Color fundus image; 1932x1932px:
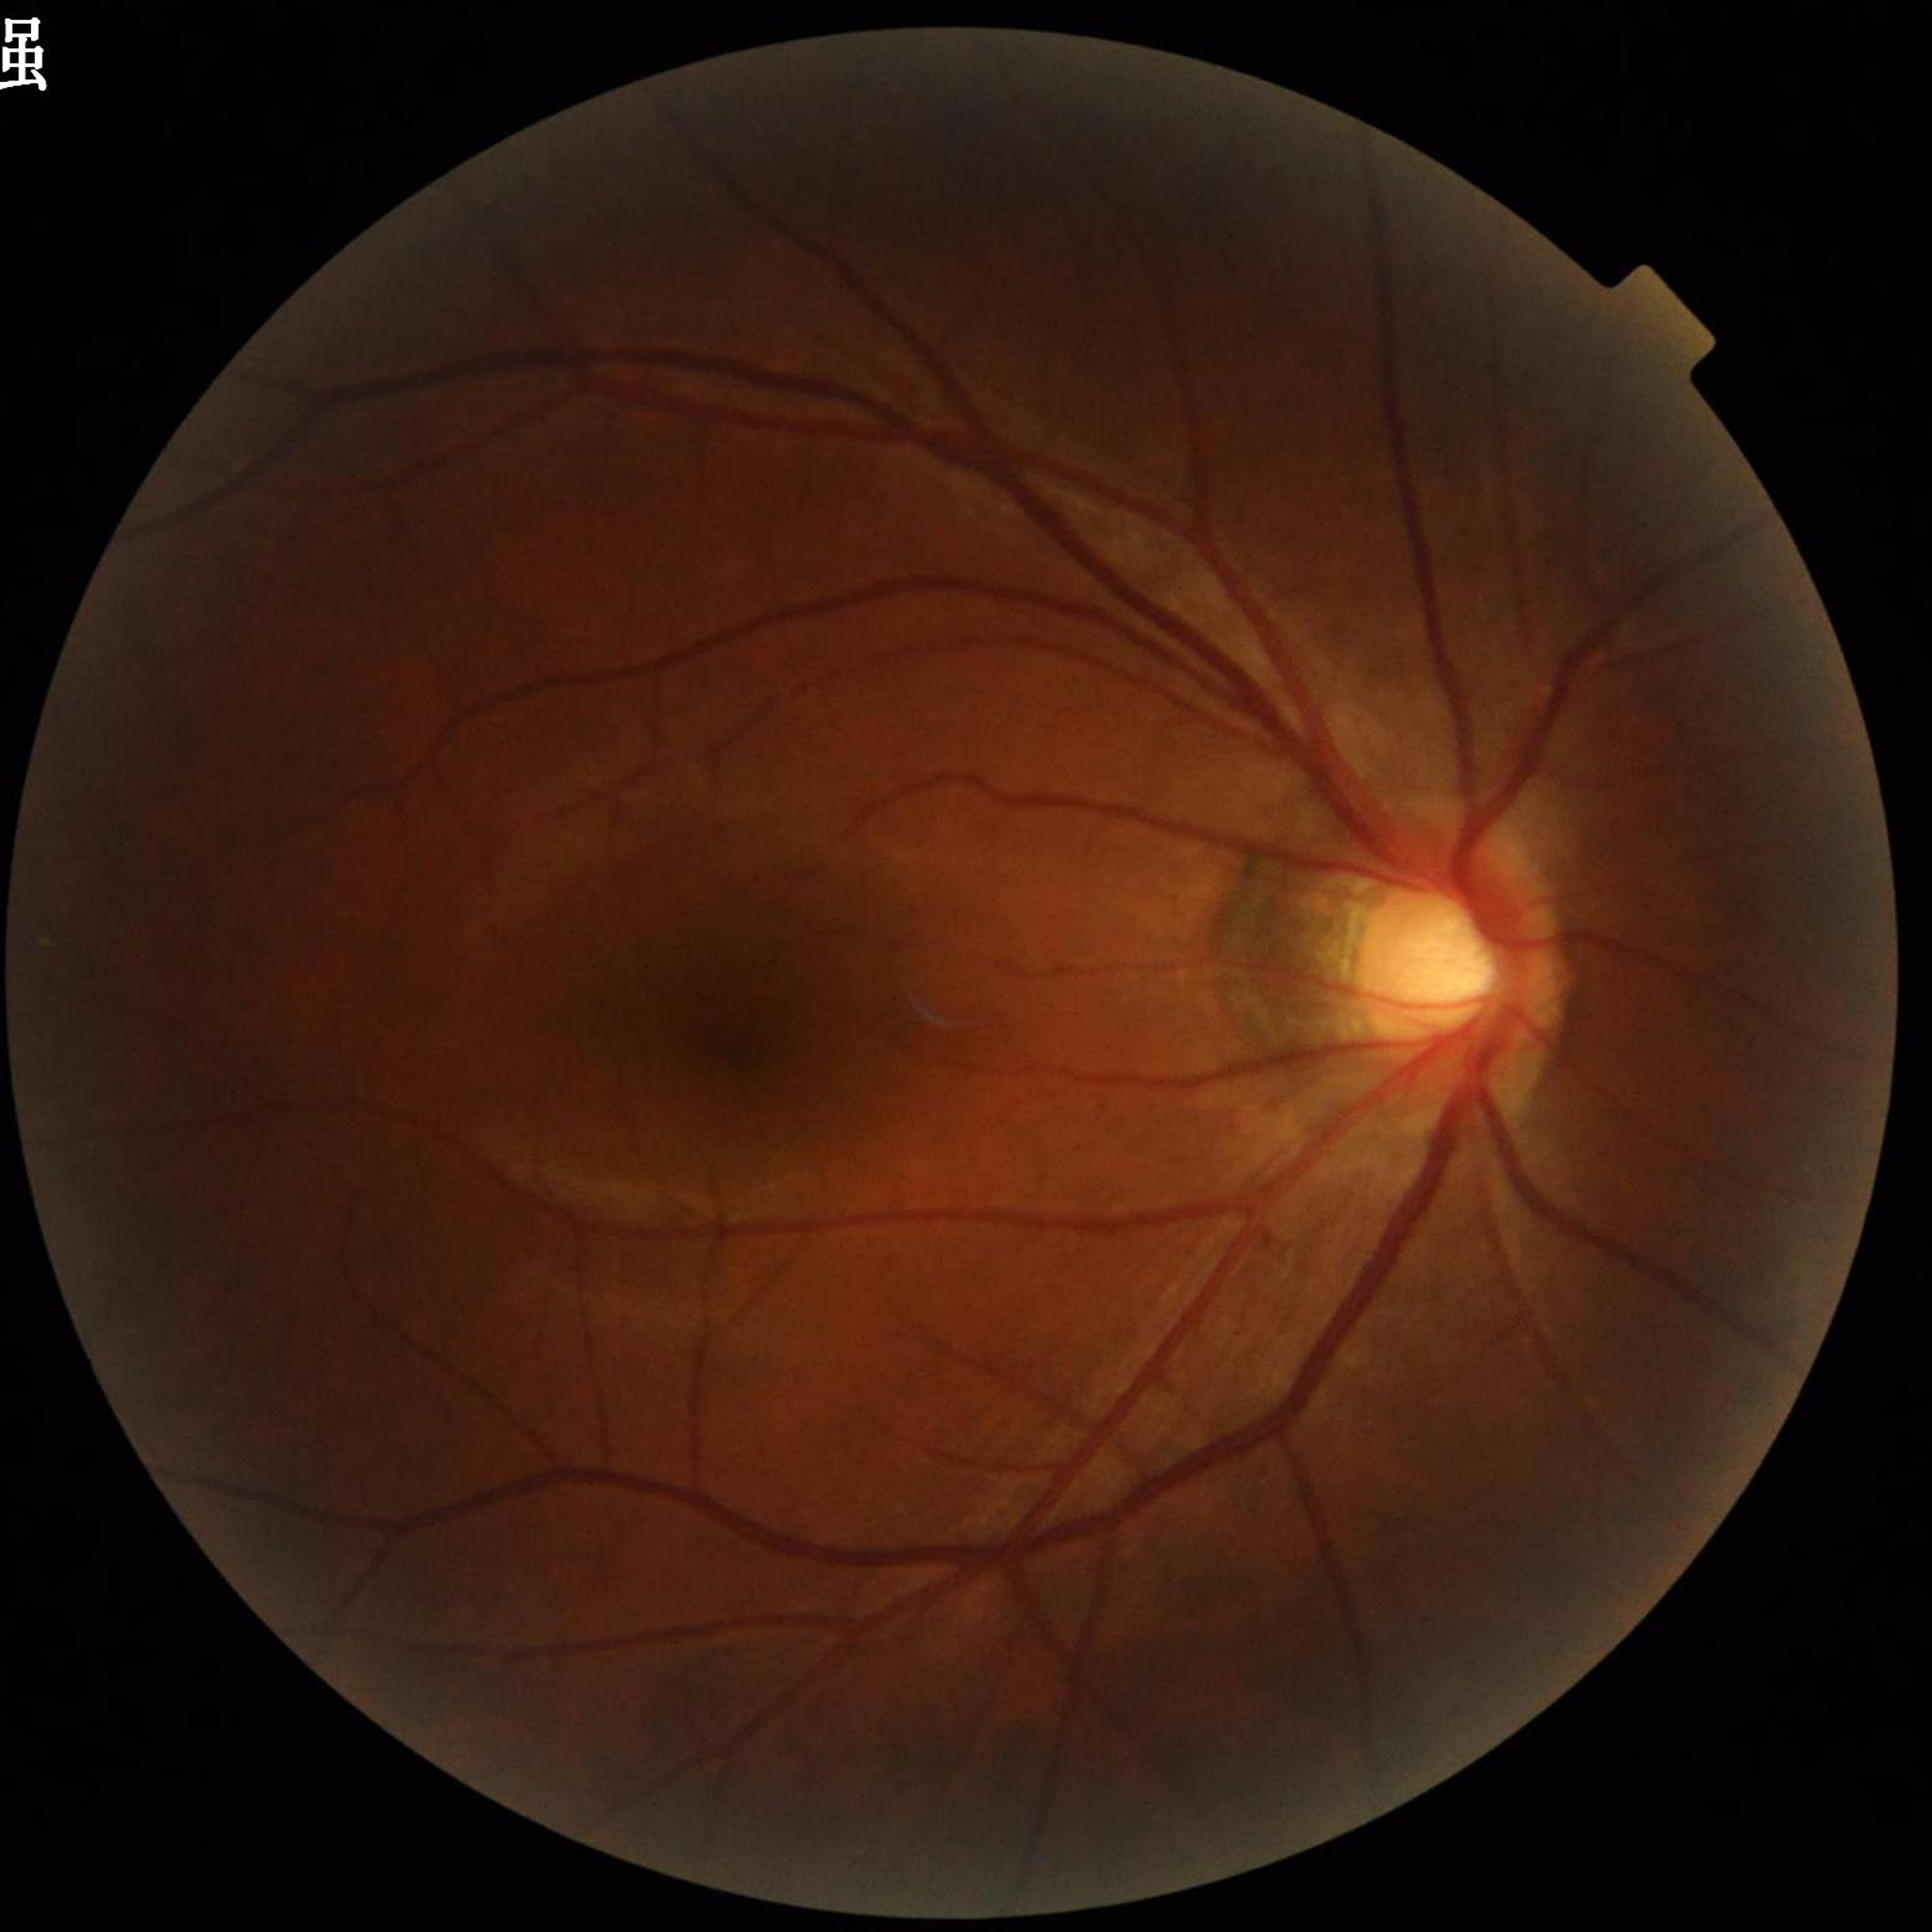 Photo quality = concerns include illumination/color distortion | Condition = glaucoma.